Modified Davis grading:
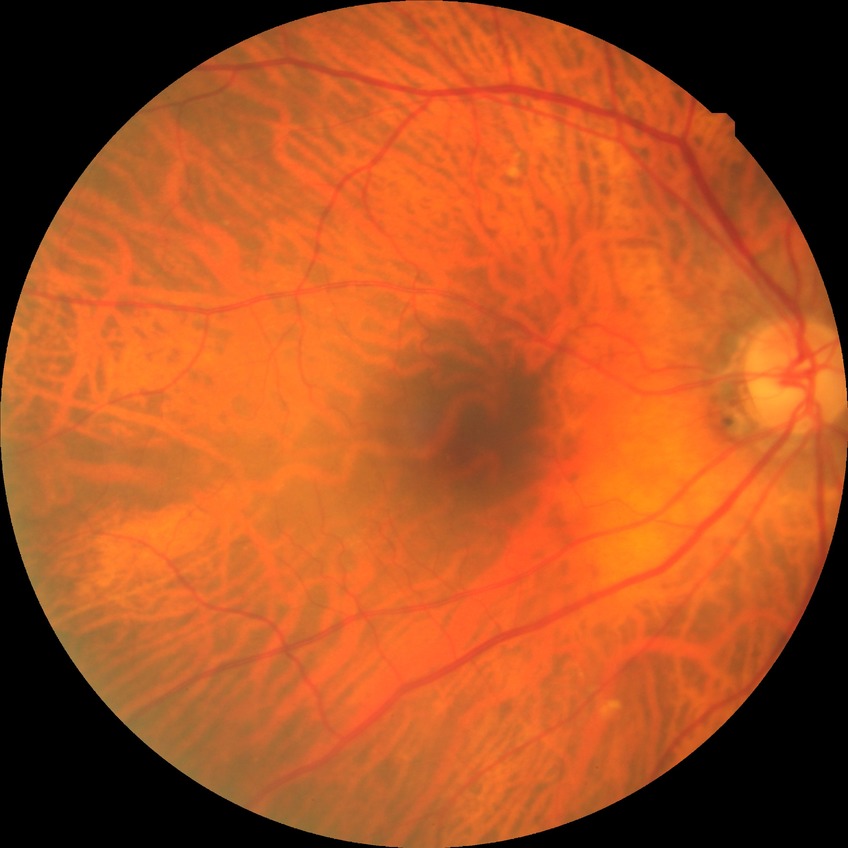 DR grade is NDR.